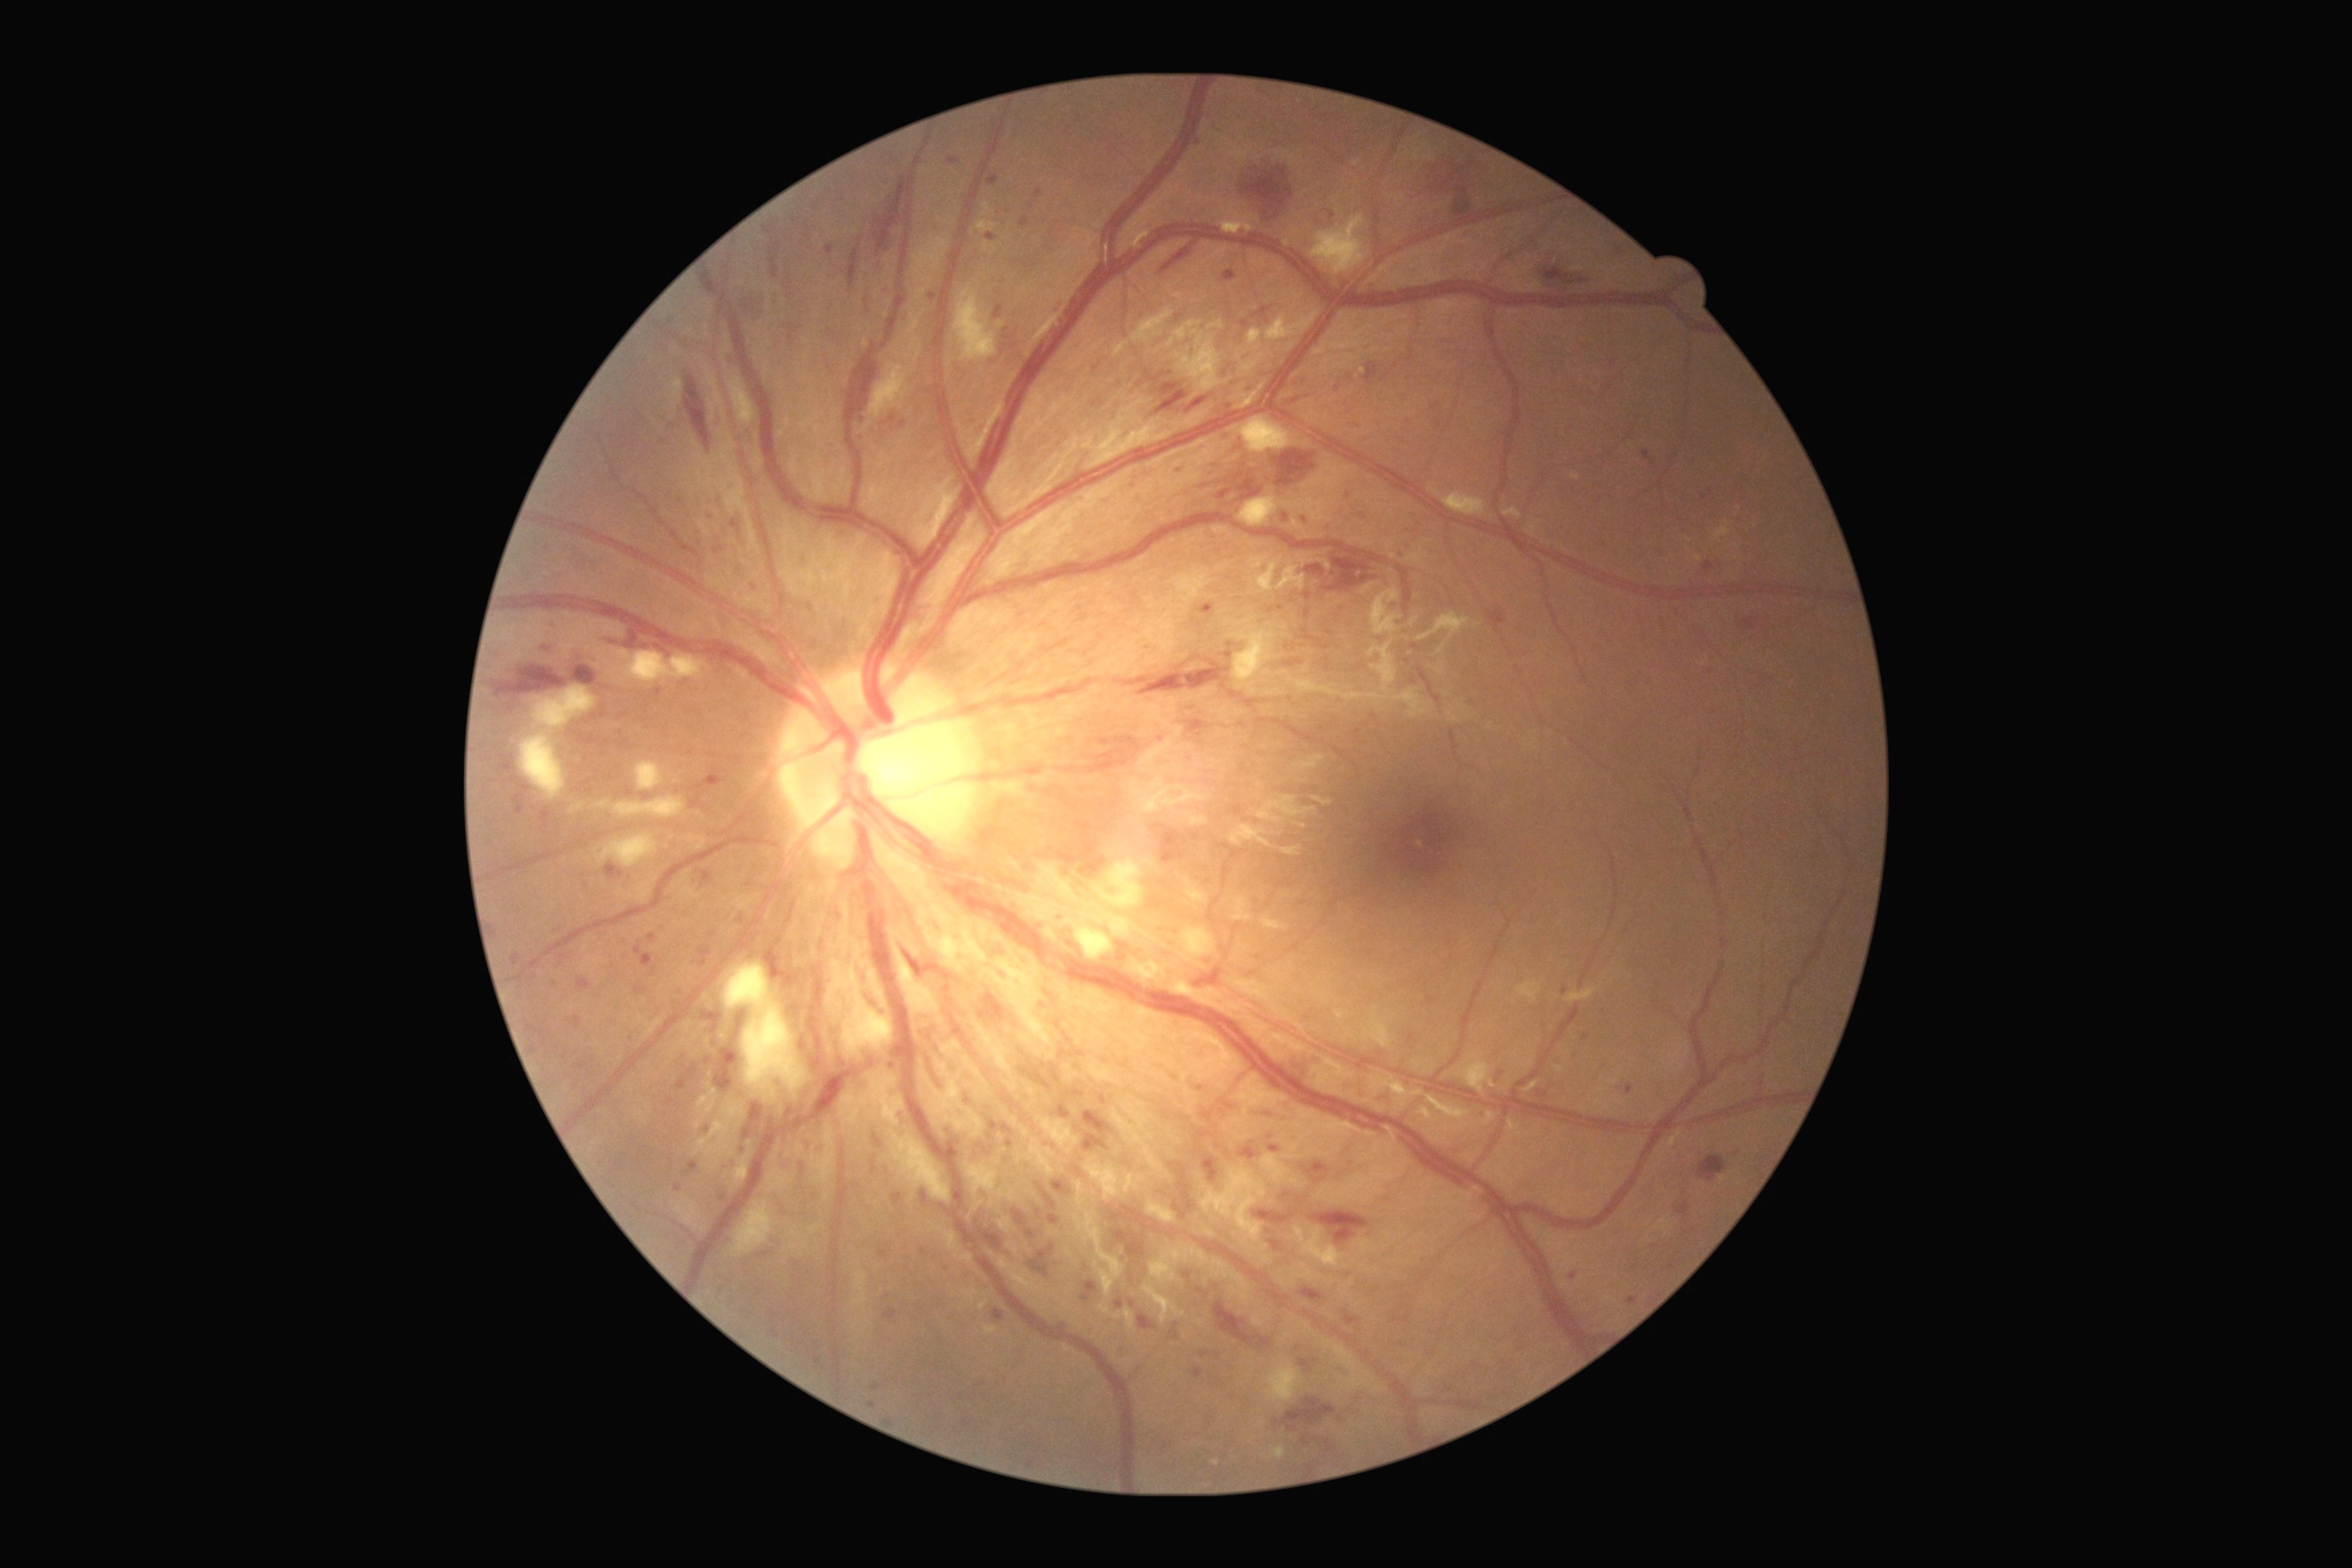

Diabetic retinopathy (DR): severe non-proliferative diabetic retinopathy (grade 3)
Lesions identified (partial list):
microaneurysms (MAs) (subset): (1099,740,1110,747); (1487,609,1505,627); (701,1012,723,1034); (1220,1101,1233,1110); (879,1250,888,1259); (1741,622,1756,631); (959,1137,966,1146); (652,968,656,977); (1200,1353,1210,1358); (511,954,522,966); (685,1162,700,1175)
Smaller MAs around <pt>1231,645</pt>; <pt>902,425</pt>; <pt>743,1151</pt>; <pt>1031,205</pt>; <pt>1040,1213</pt>; <pt>1436,407</pt>; <pt>1333,216</pt>; <pt>863,439</pt>